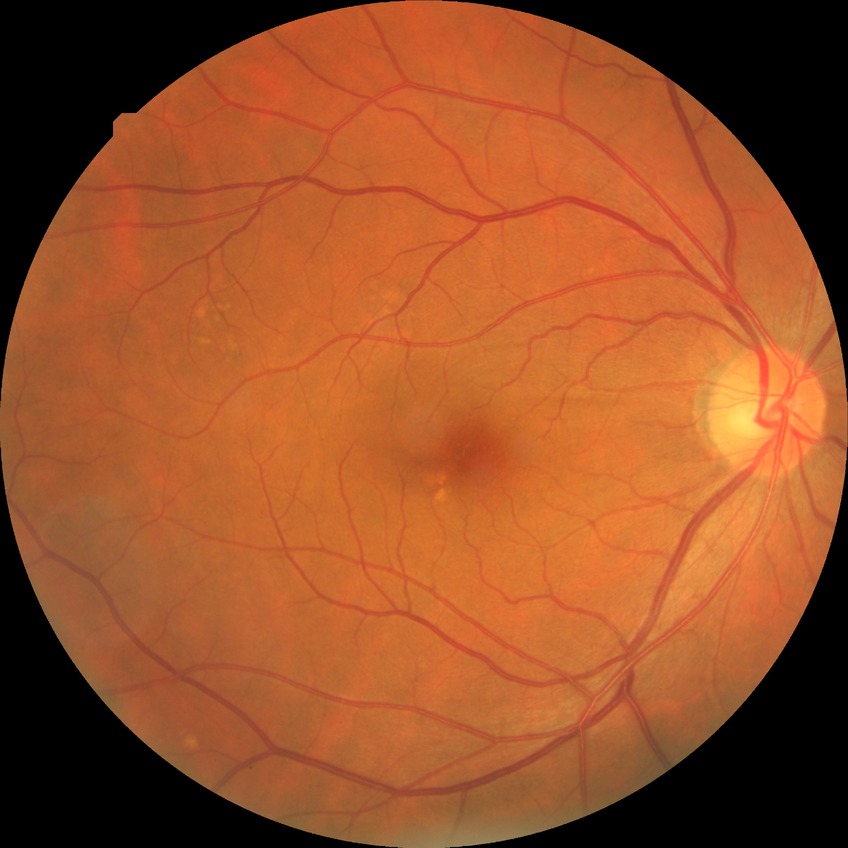
Diabetic retinopathy (DR) is no diabetic retinopathy (NDR).